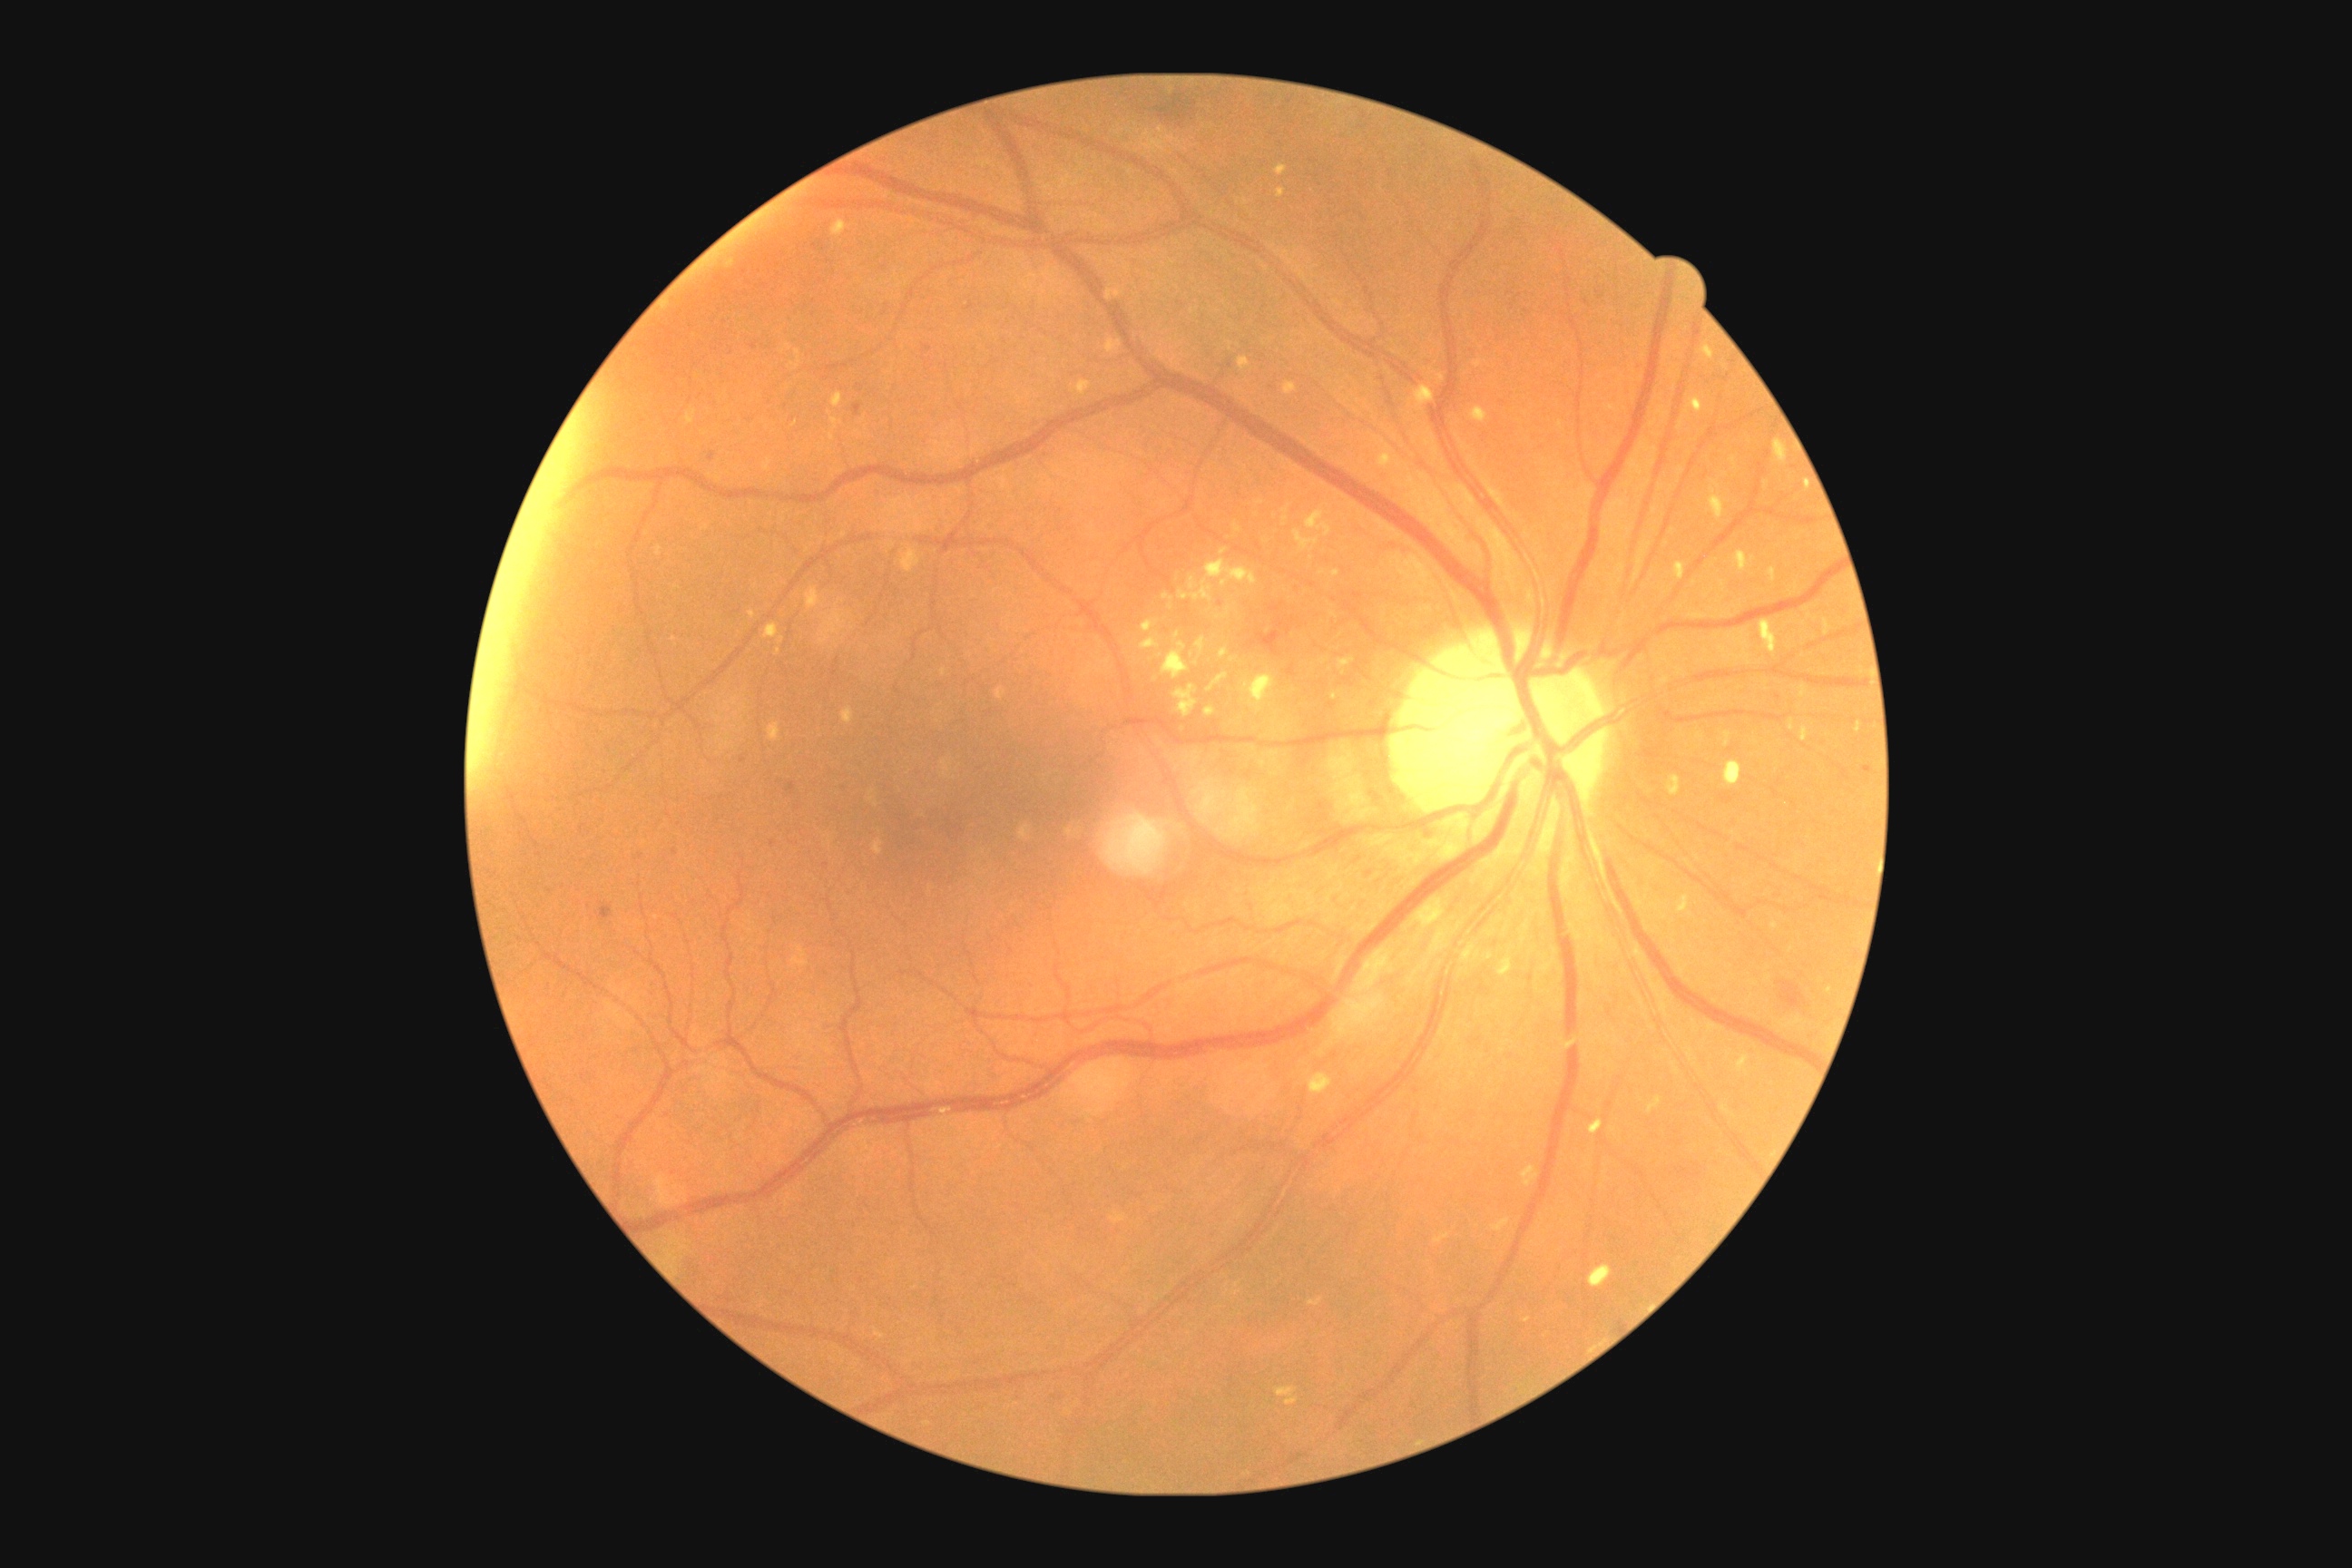

Diabetic retinopathy (DR): 2
Lesions identified (partial list):
• soft exudates (SEs) (partial): (x1=1242, y1=672, x2=1277, y2=714) | (x1=1275, y1=1387, x2=1298, y2=1406) | (x1=1141, y1=636, x2=1161, y2=651) | (x1=1173, y1=683, x2=1199, y2=716) | (x1=1142, y1=620, x2=1159, y2=632) | (x1=1190, y1=574, x2=1200, y2=591) | (x1=1220, y1=649, x2=1230, y2=660) | (x1=1224, y1=607, x2=1231, y2=618) | (x1=1197, y1=638, x2=1206, y2=654)
• SEs (small, approximate centers) near (x=1232, y=660) | (x=1197, y=663)